Retinal fundus photograph; 45-degree field of view: 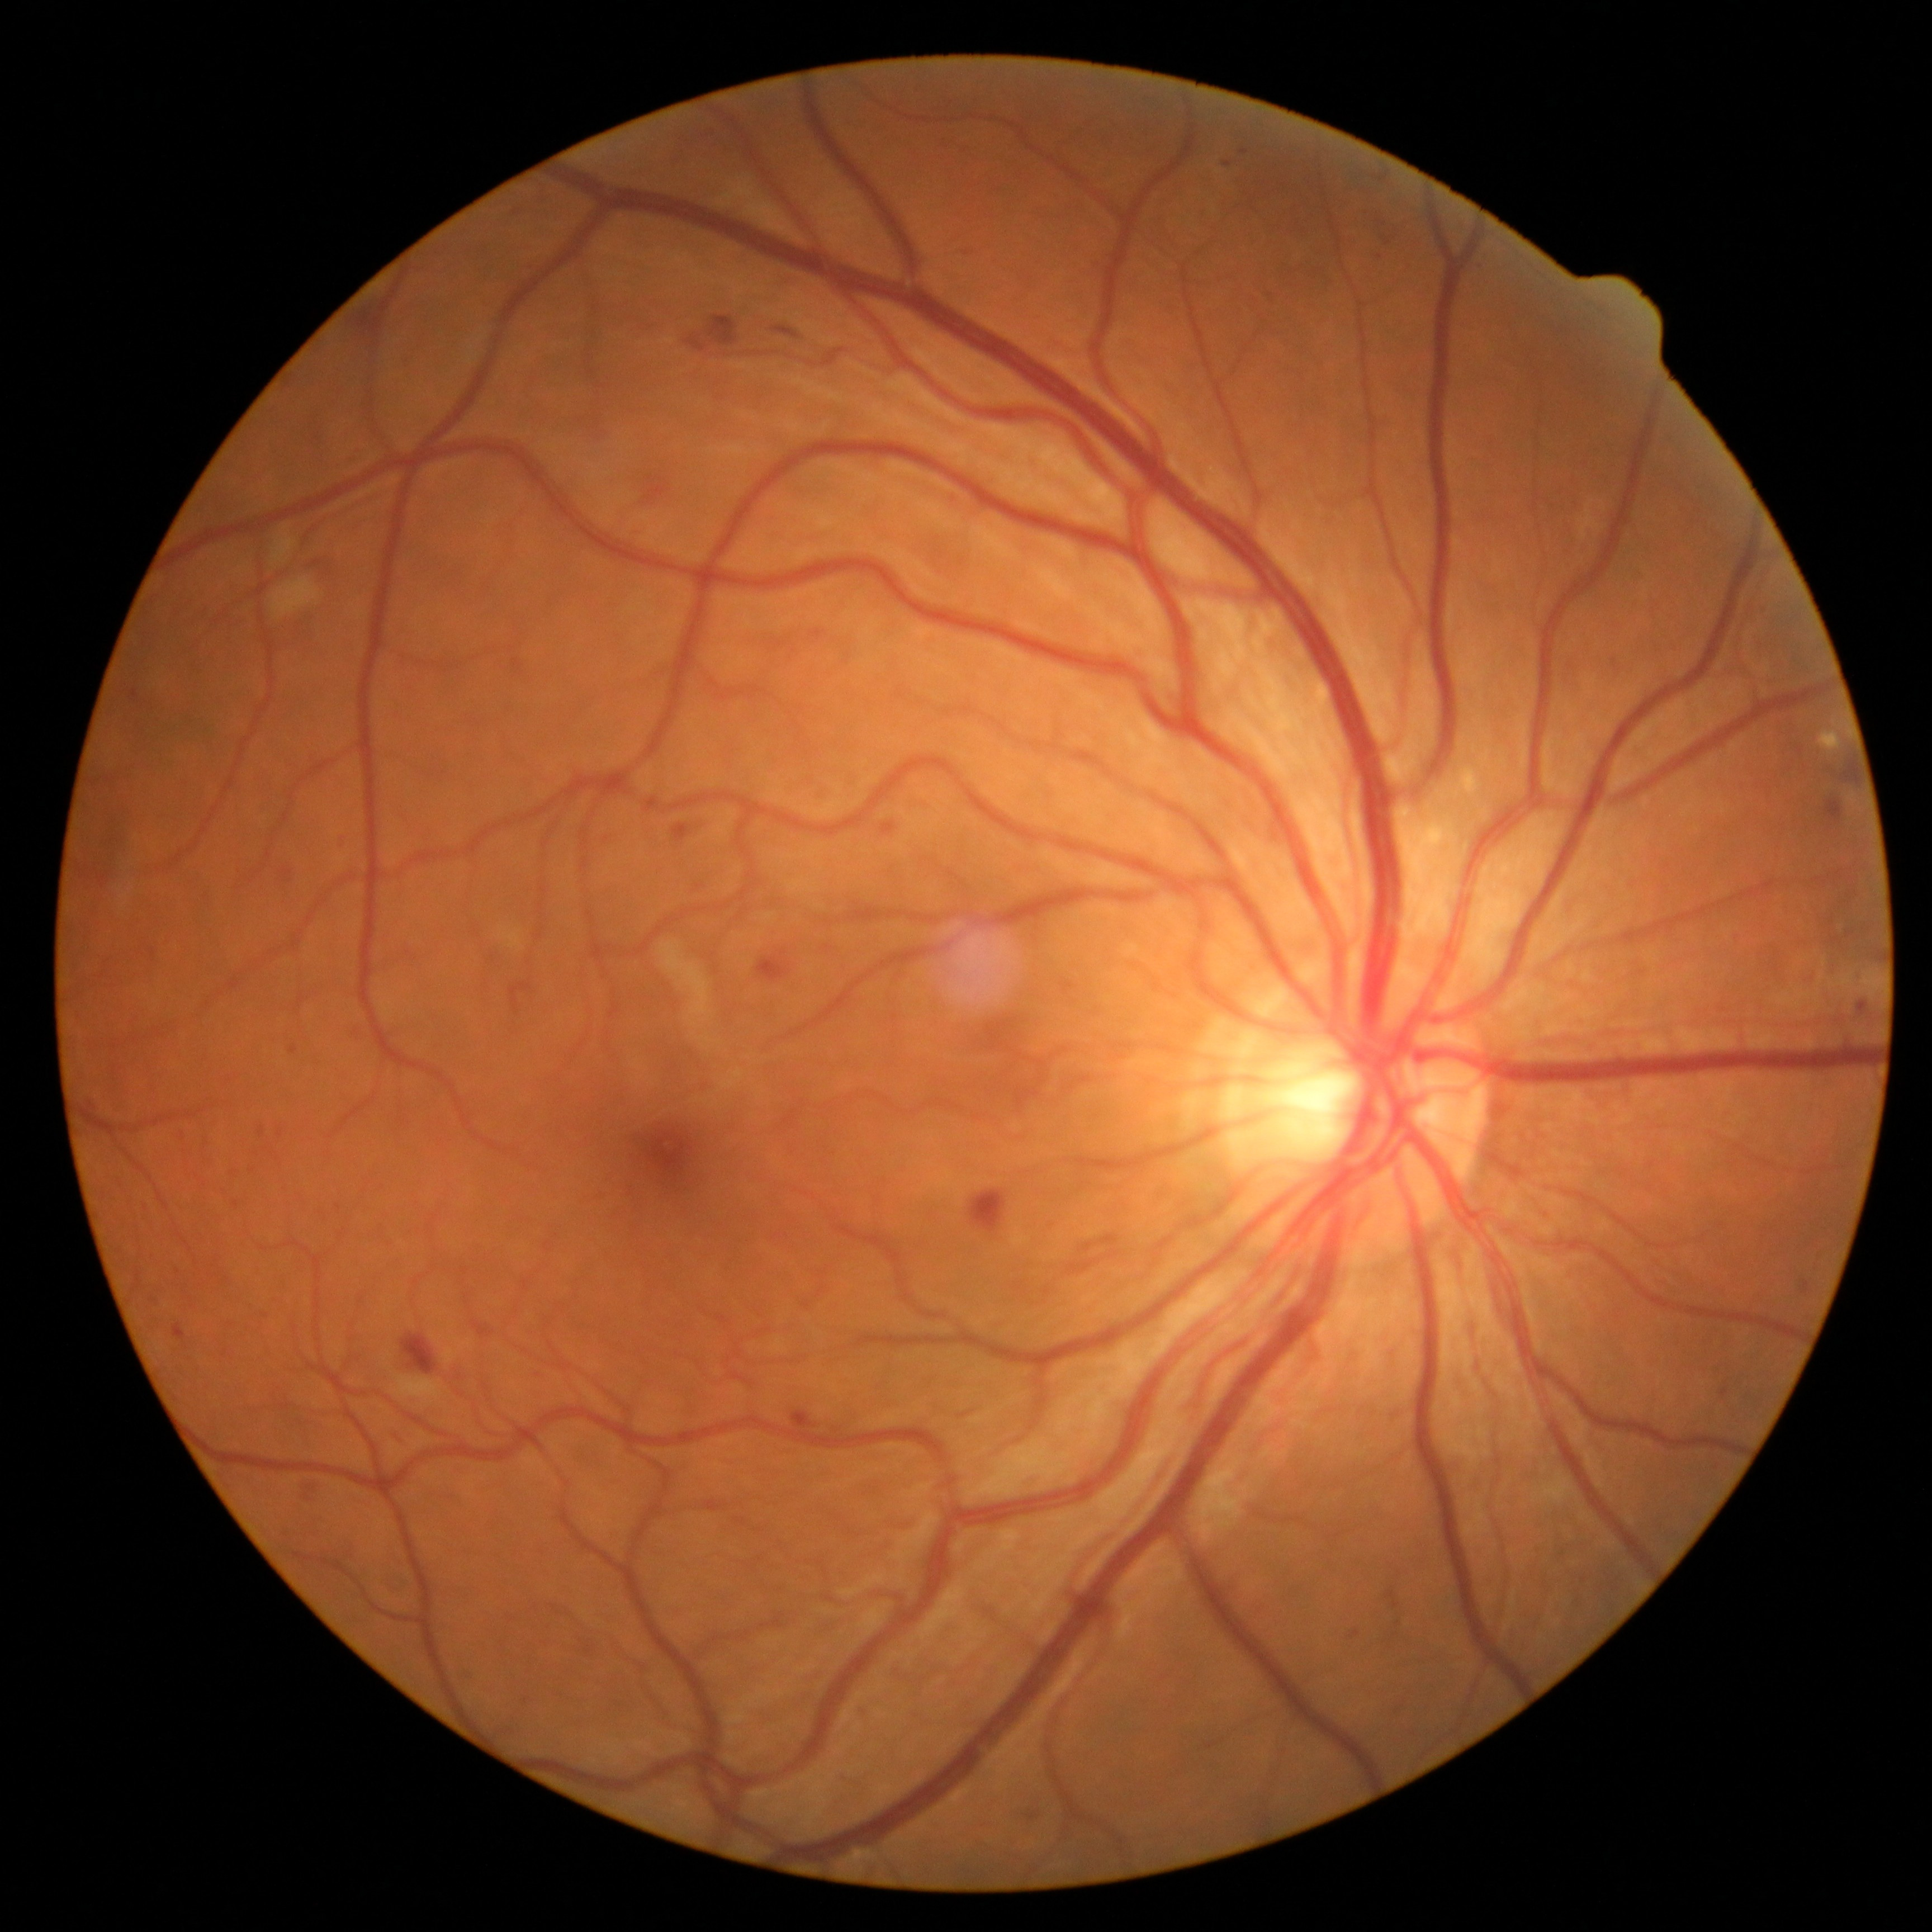 Diabetic retinopathy severity is grade 2.